Camera: Clarity RetCam 3 (130° FOV); pediatric retinal photograph (wide-field); 640 by 480 pixels — 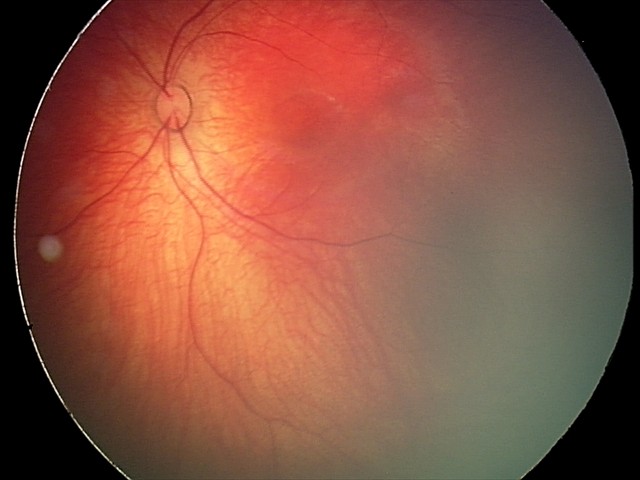 Q: What was the screening finding?
A: retinal hemorrhages